Camera: Forus 3Nethra Classic fundus camera; color fundus photograph:
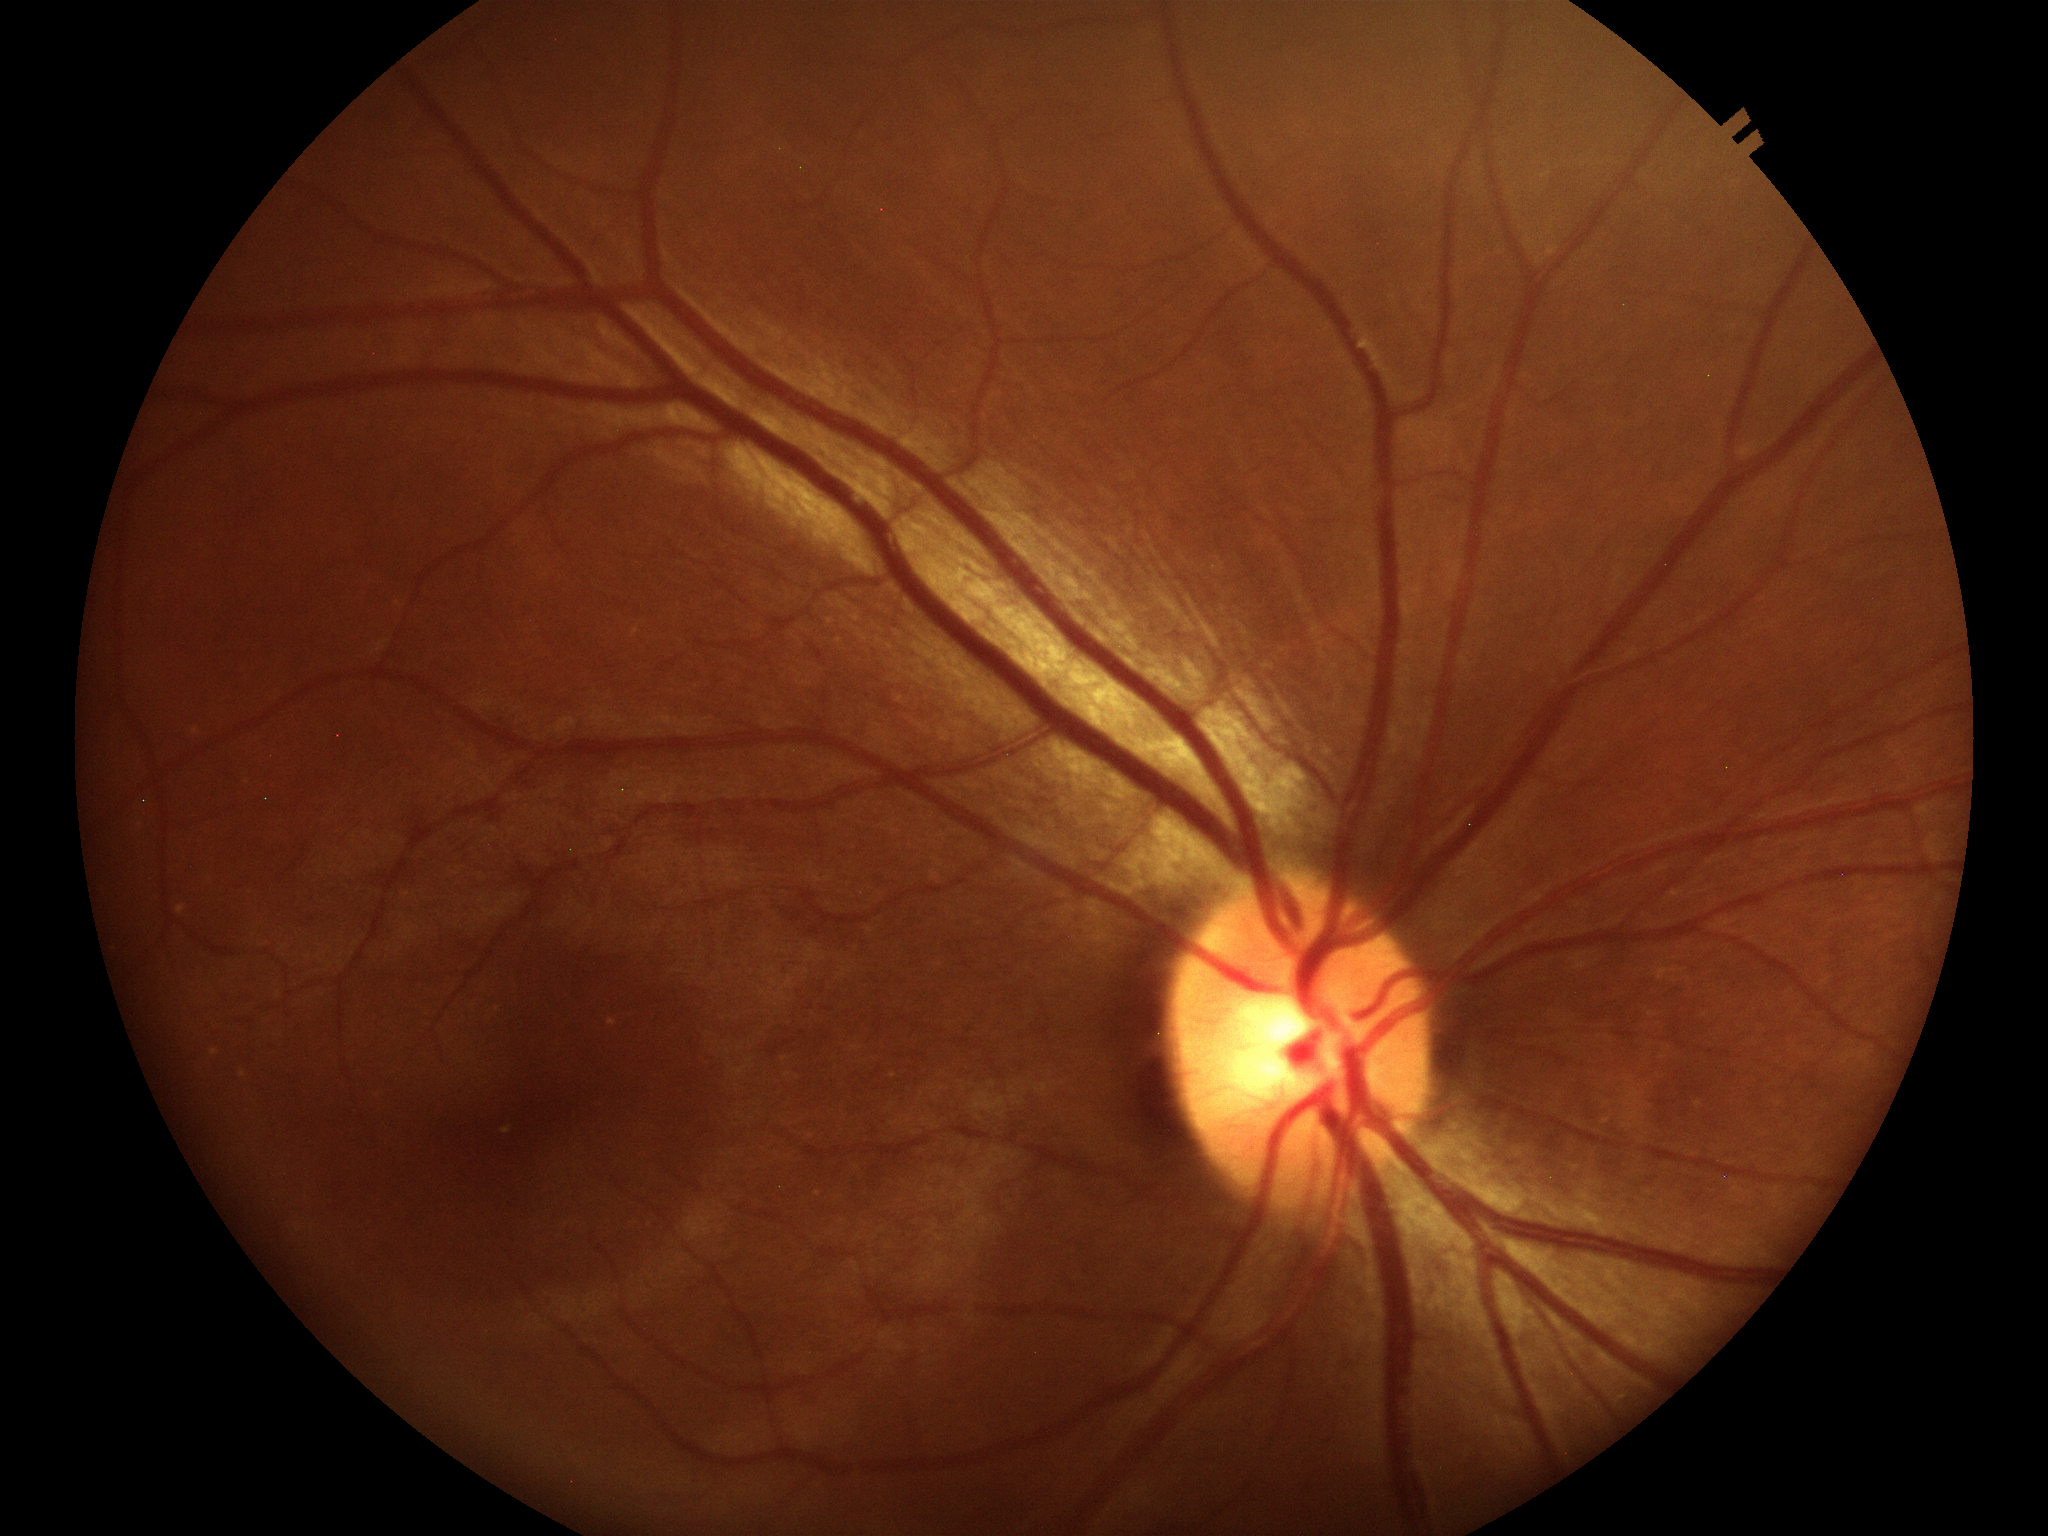

Glaucoma decision: not suspect | horizontal cup-disc ratio (HCDR): 0.50 | vertical CDR (VCDR): 0.46